Disc-centered fundus crop, Topcon TRC fundus camera, 376x376px:
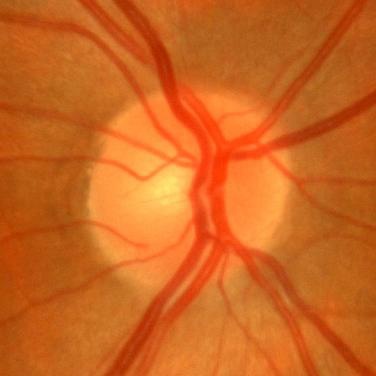
Q: Does this eye have glaucoma?
A: No — no signs of glaucoma.